Modified Davis classification. Camera: NIDEK AFC-230
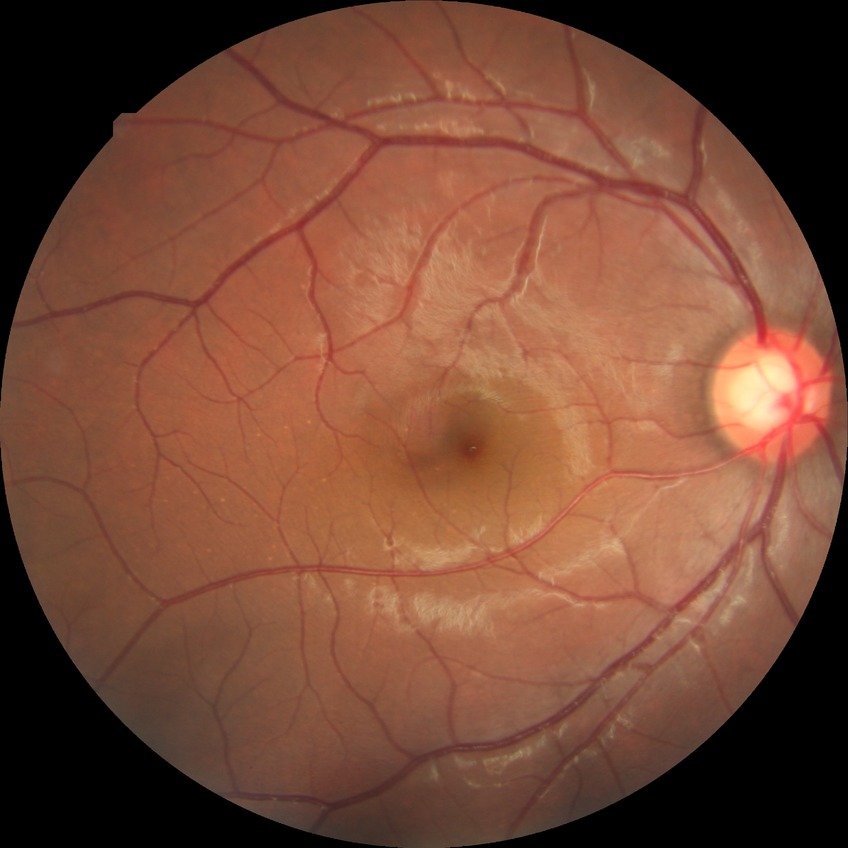 Diabetic retinopathy severity: no diabetic retinopathy.